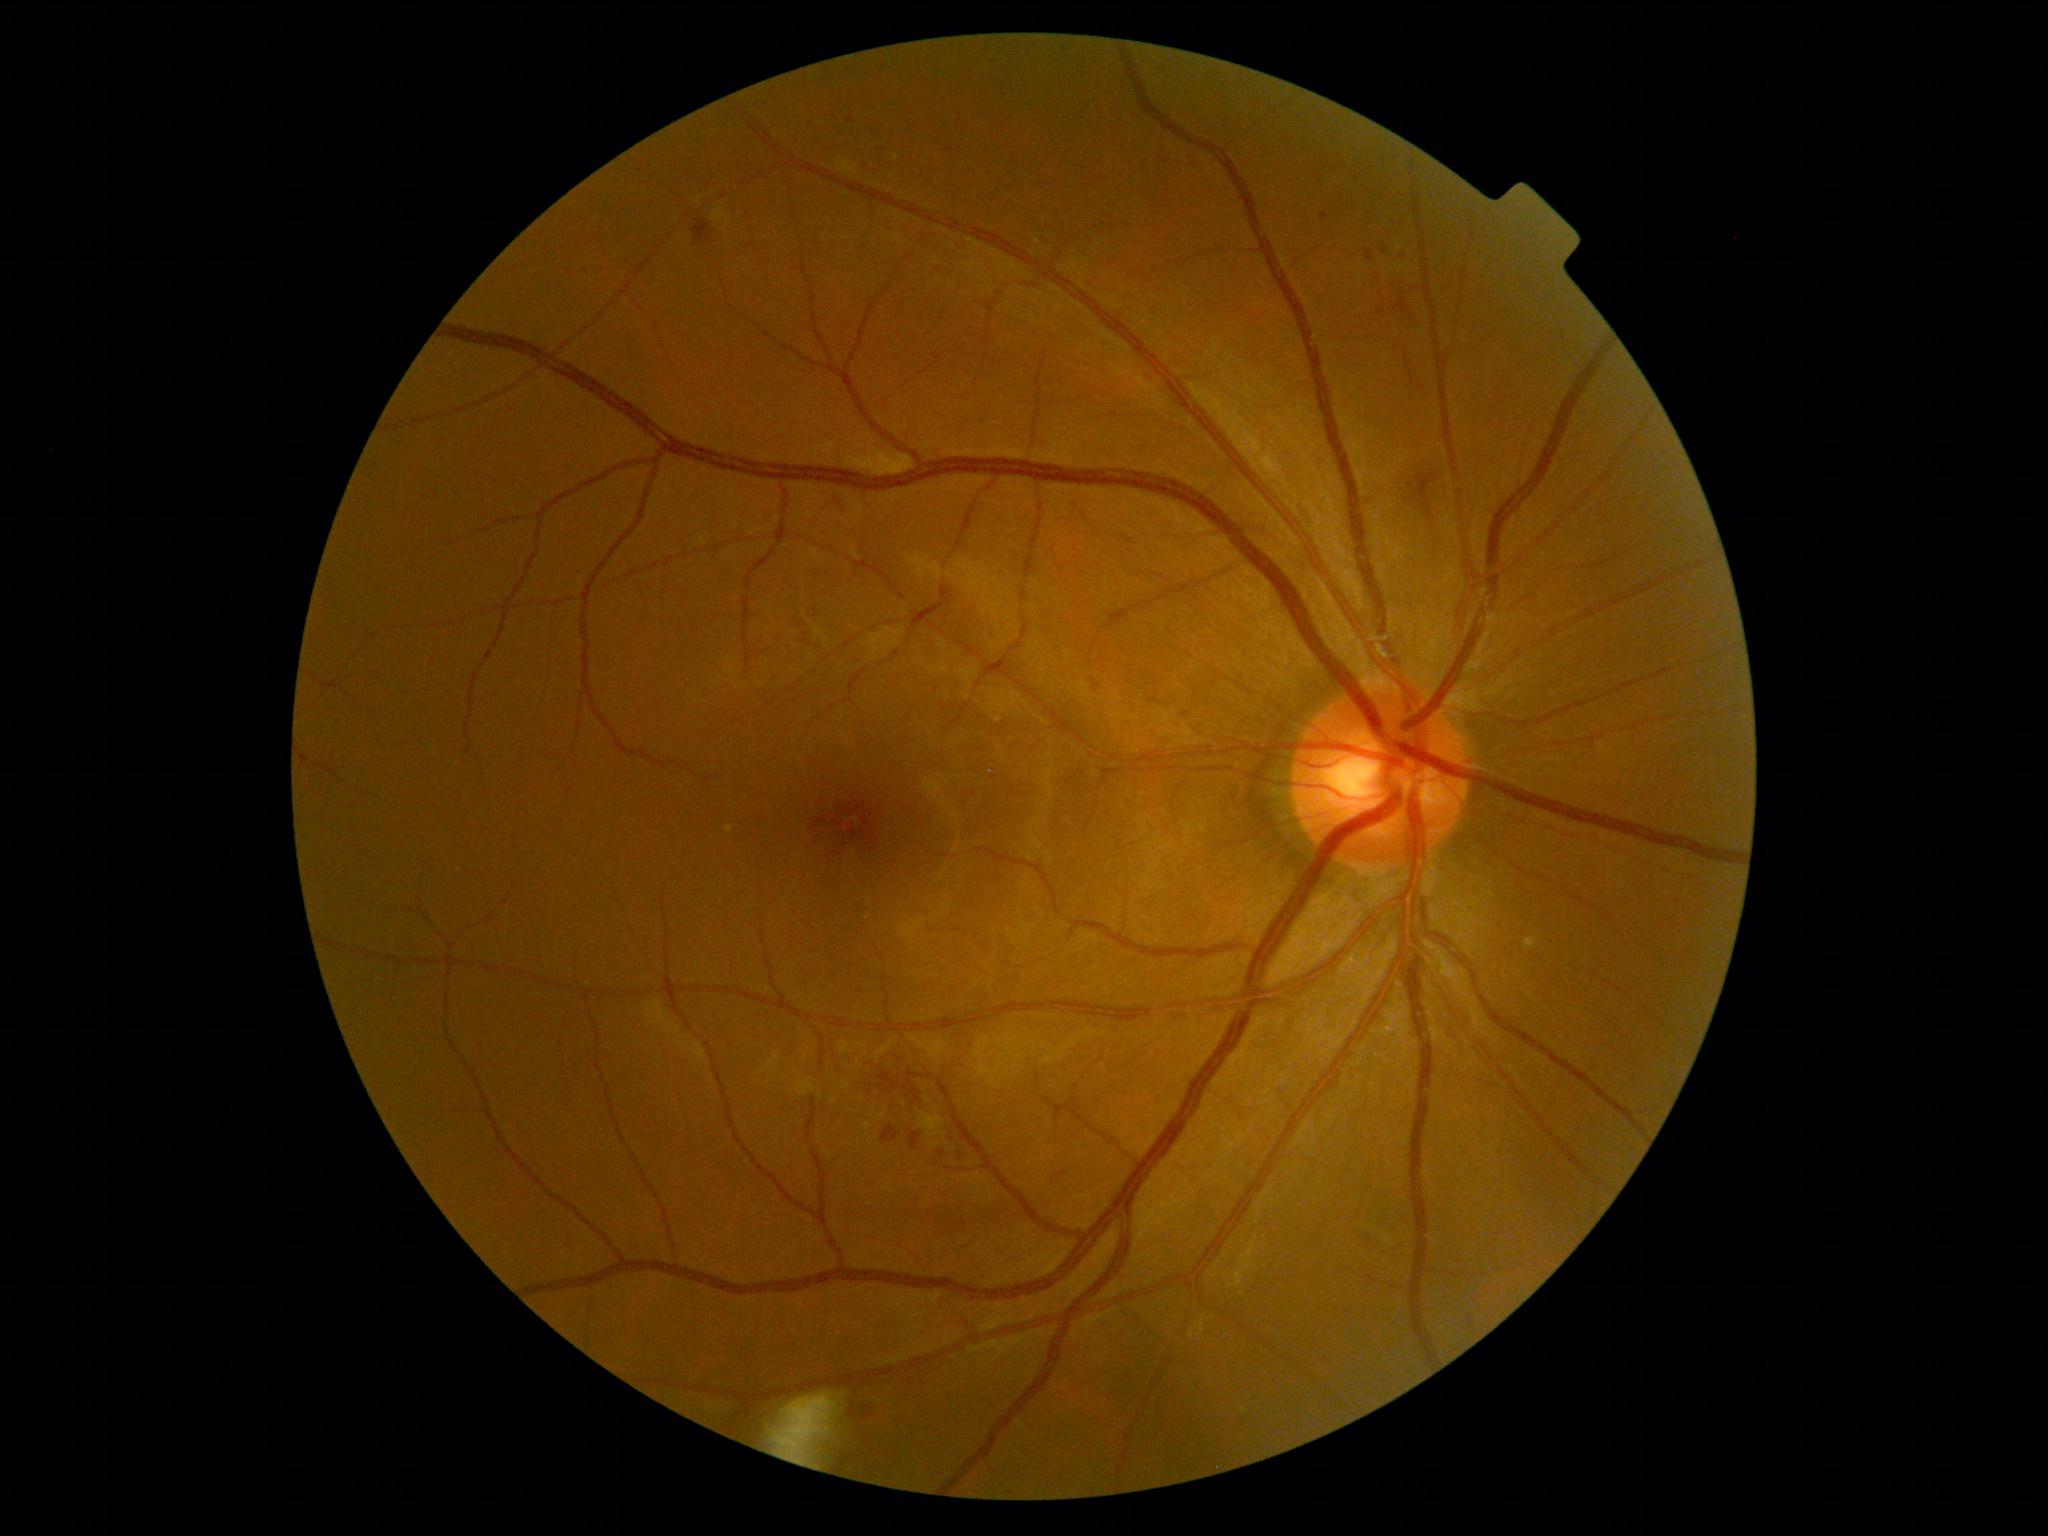 DR class: non-proliferative diabetic retinopathy, diabetic retinopathy grade: 2/4.